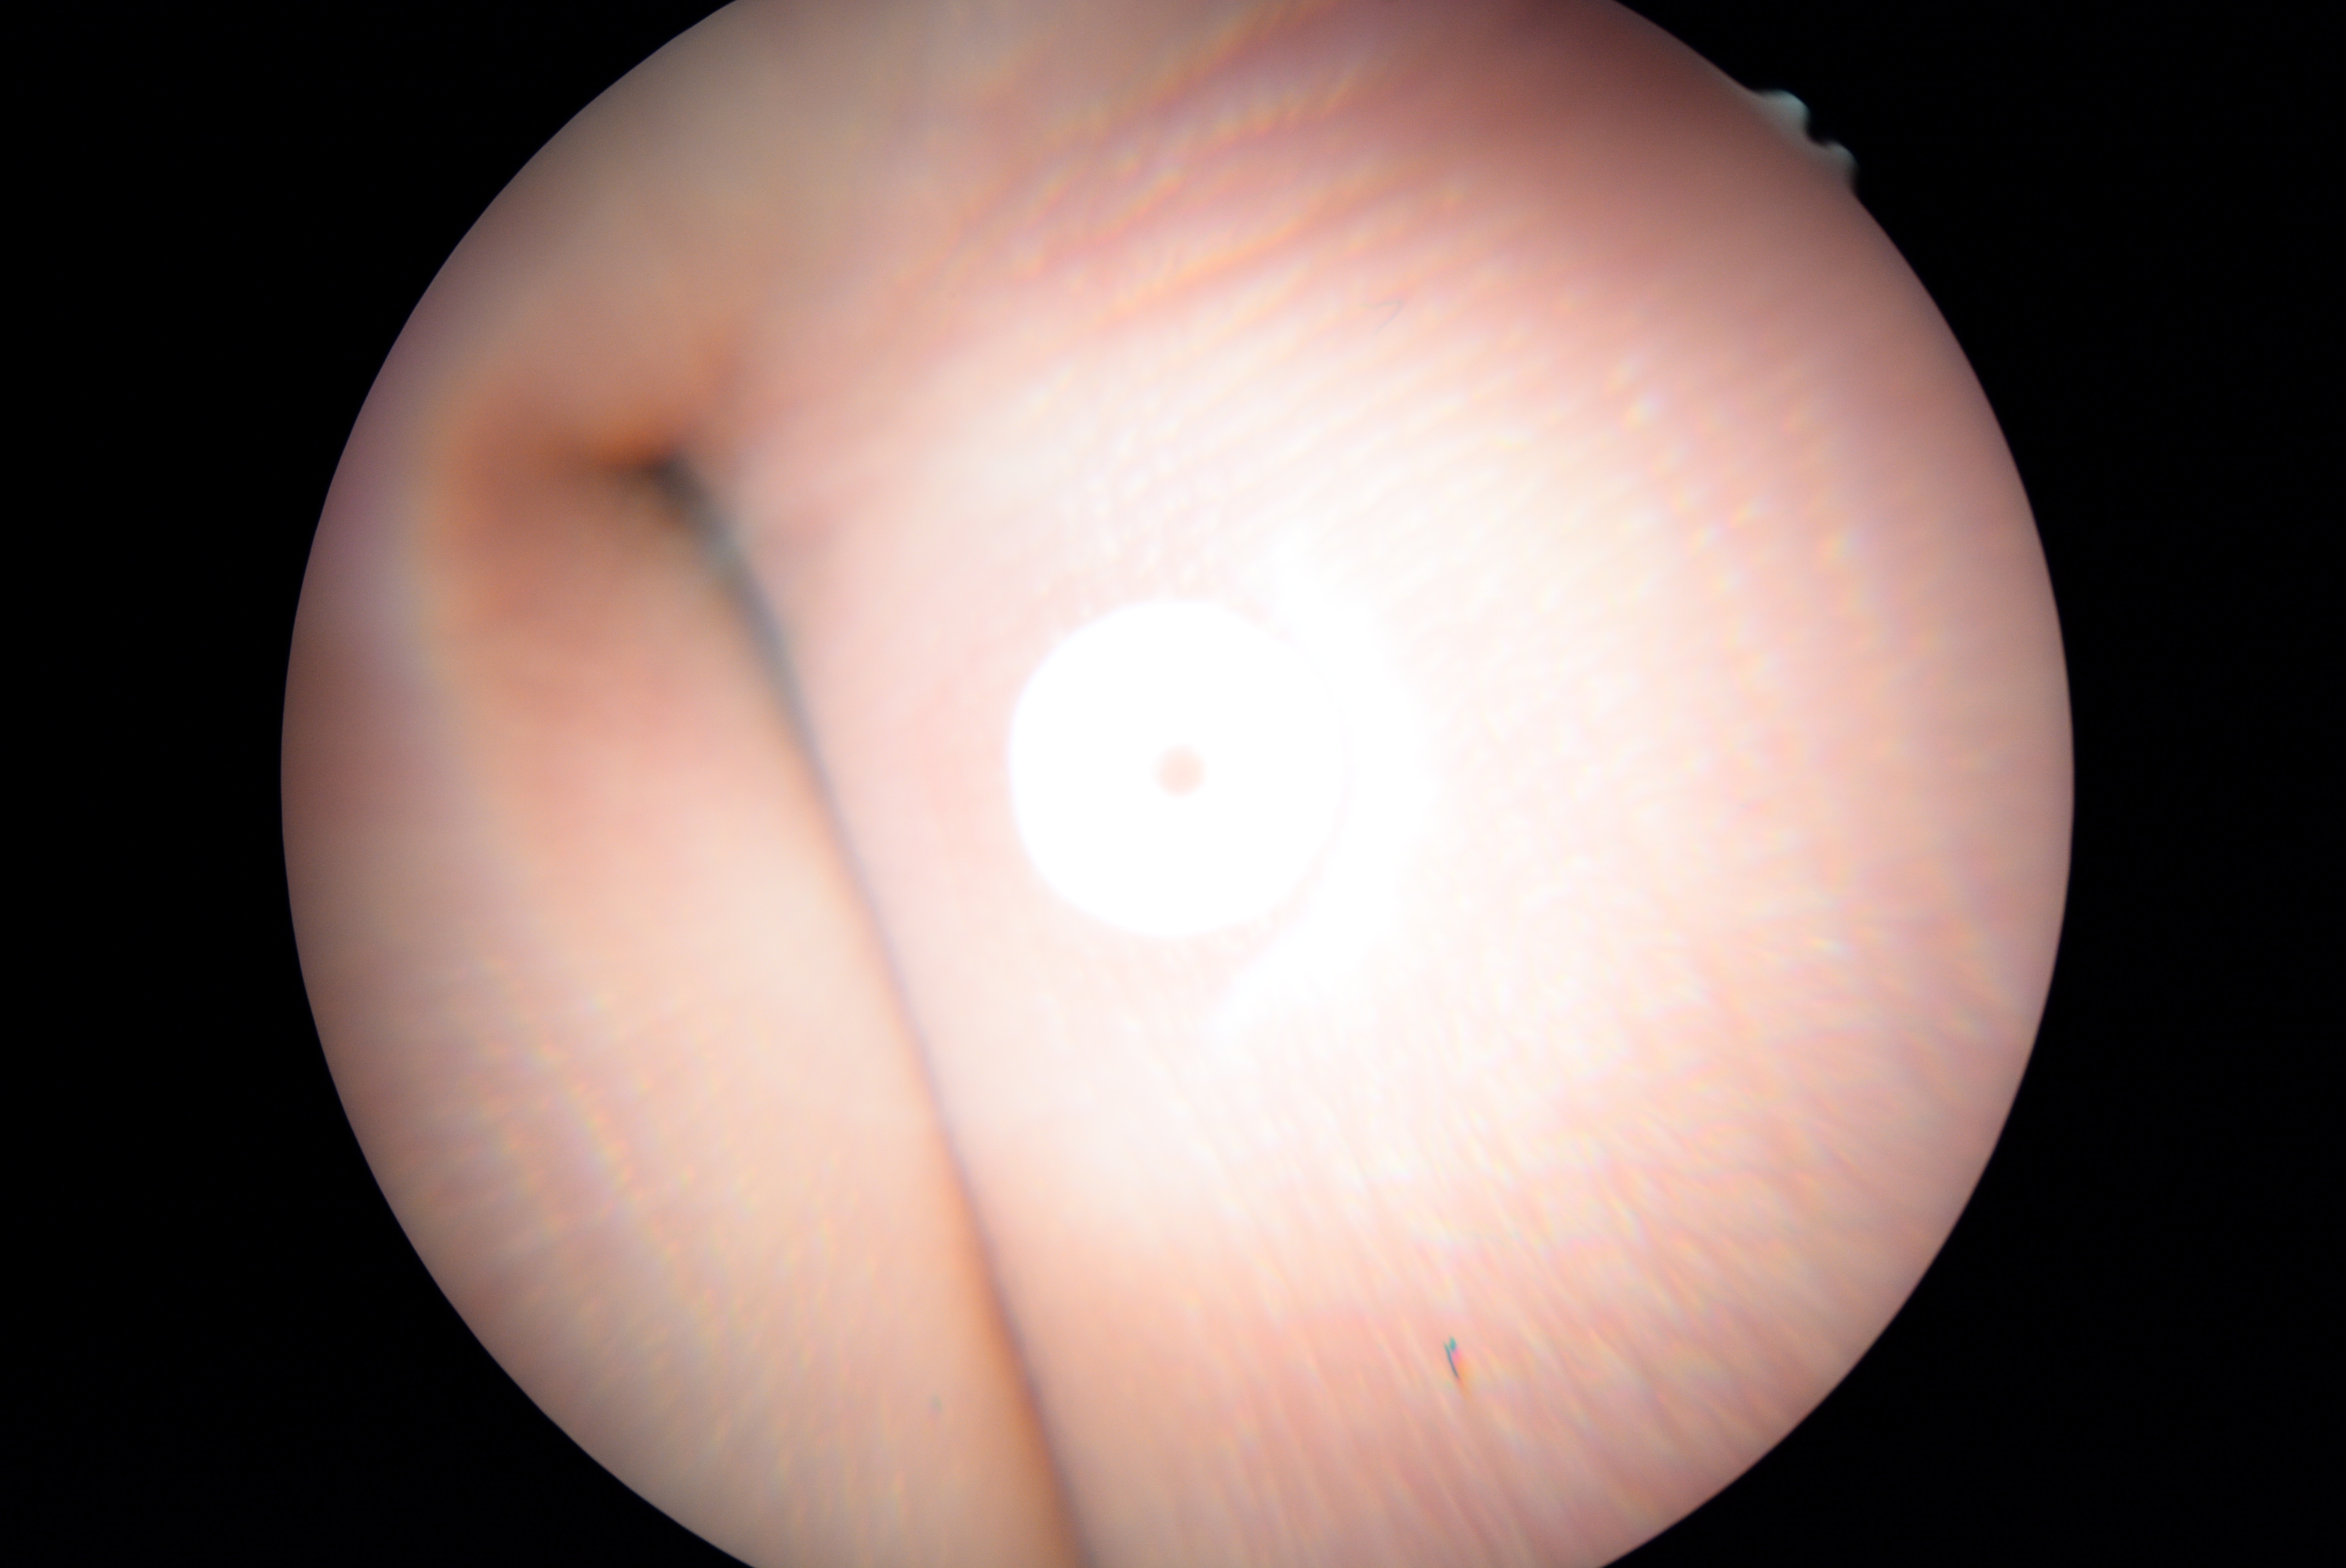 The image cannot be graded for diabetic retinopathy.
Retinopathy is ungradable due to poor image quality.